CFP · acquired with a NIDEK AFC-230 · 848 by 848 pixels
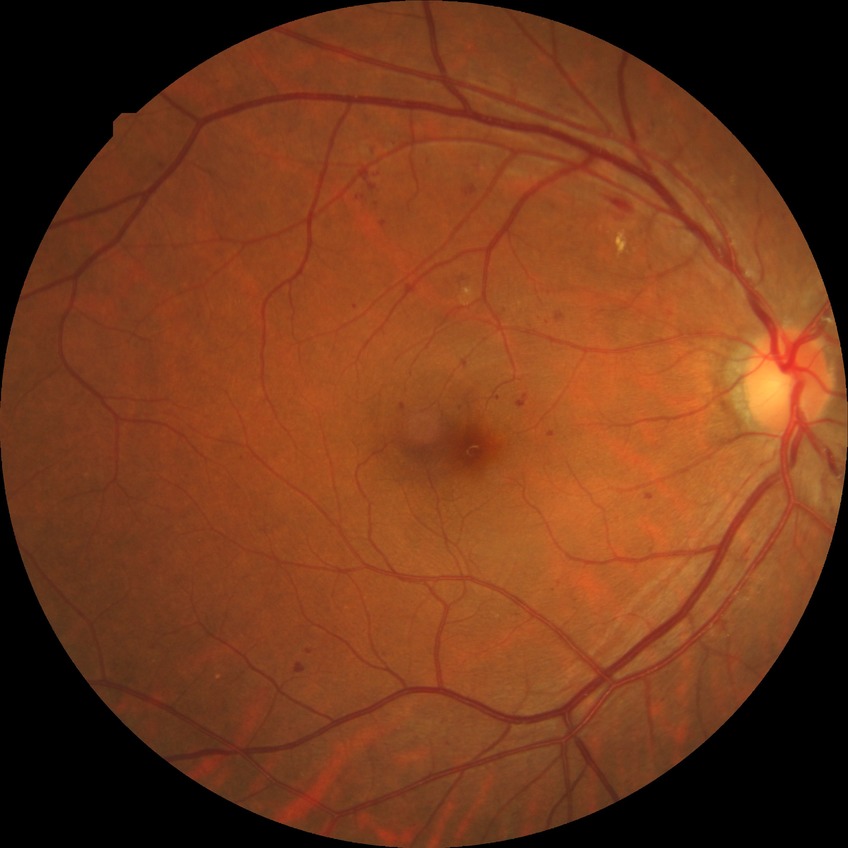 Diabetic retinopathy grade: pre-proliferative diabetic retinopathy.
Disease class: non-proliferative diabetic retinopathy.